Infant wide-field retinal image; Natus RetCam Envision, 130° FOV.
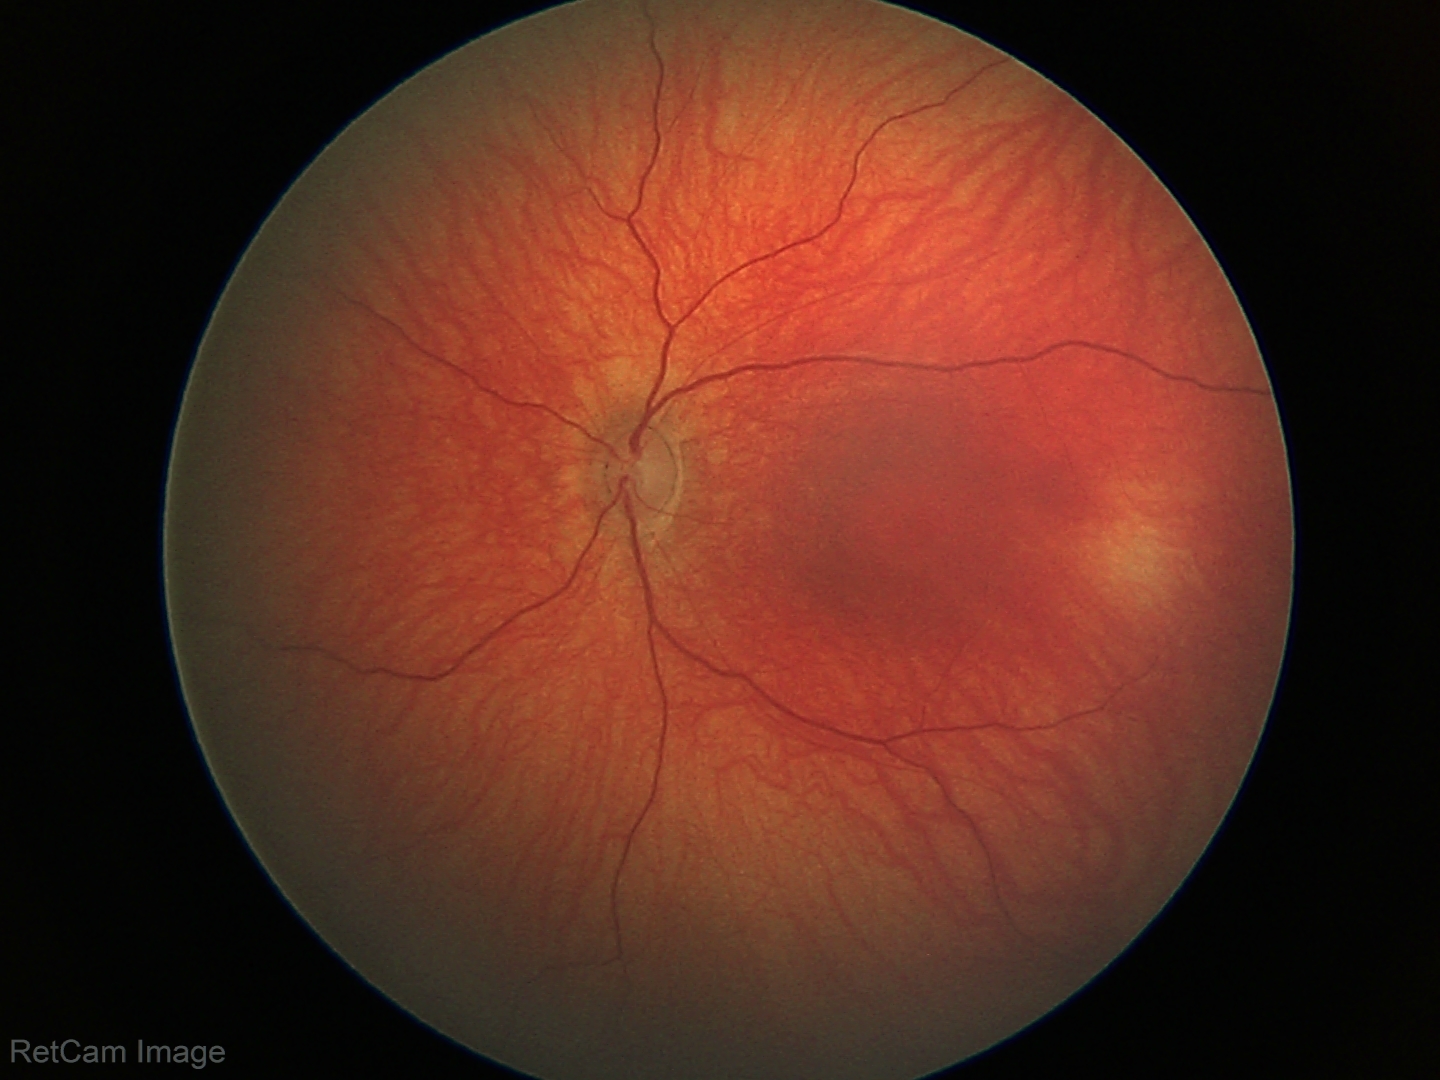

Q: What is the diagnosis from this examination?
A: normal fundus examination